Natus RetCam Envision, 130° FOV · 1440x1080 · pediatric wide-field fundus photograph:
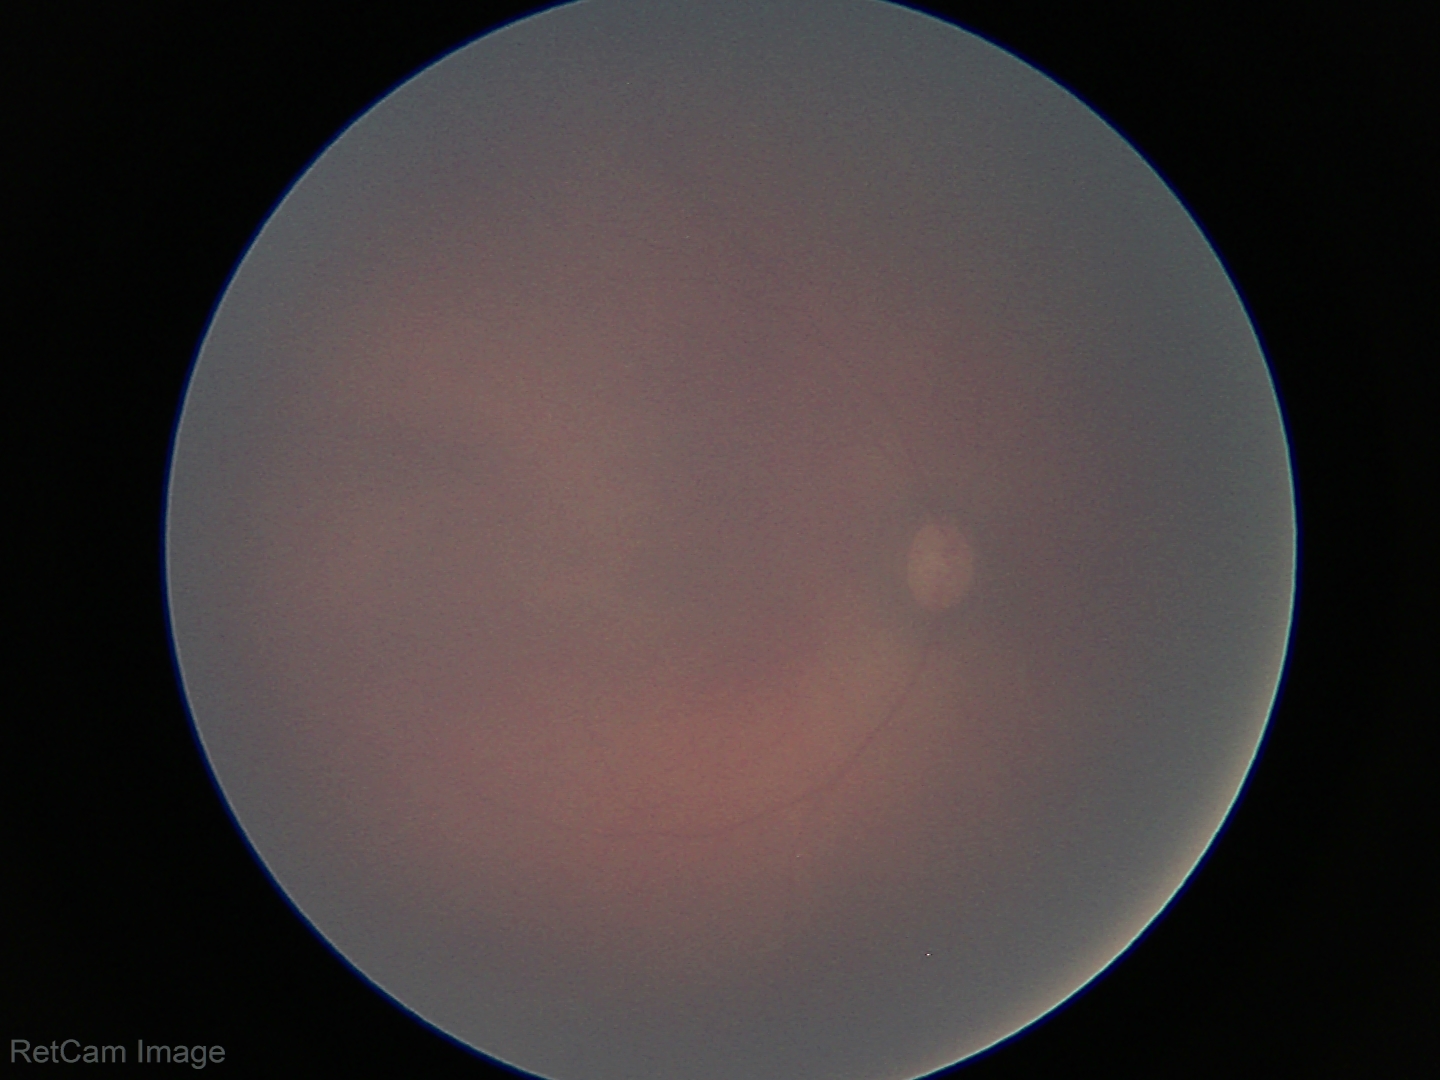
Screening: physiological retinal finding.